Graded on the modified Davis scale · 848x848px · nonmydriatic.
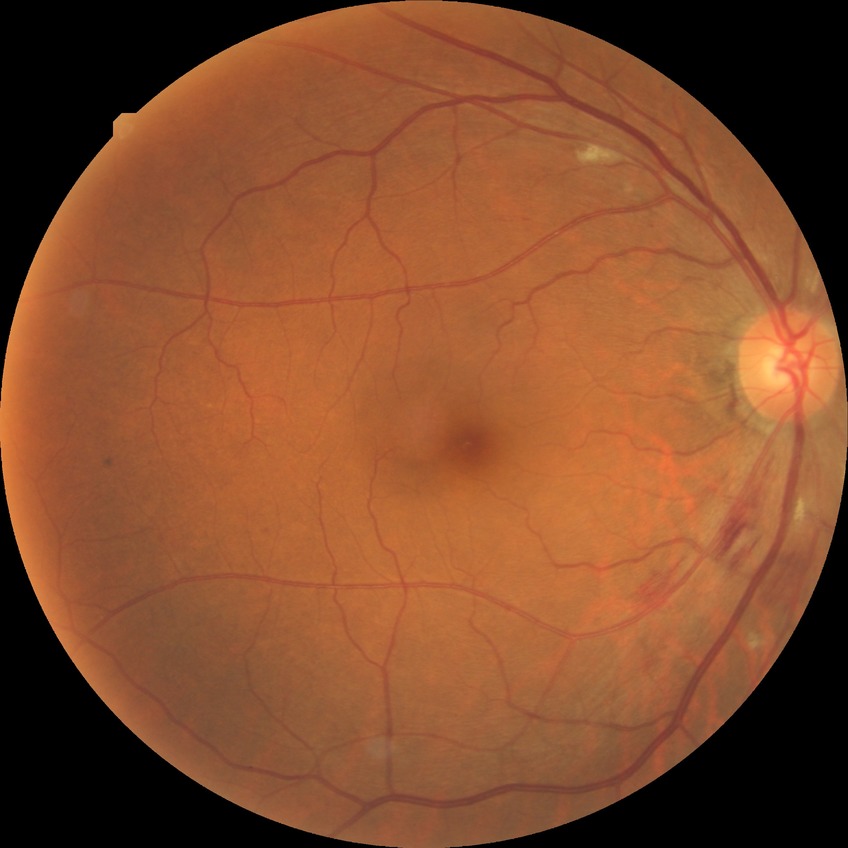 Diabetic retinopathy severity: pre-proliferative diabetic retinopathy.